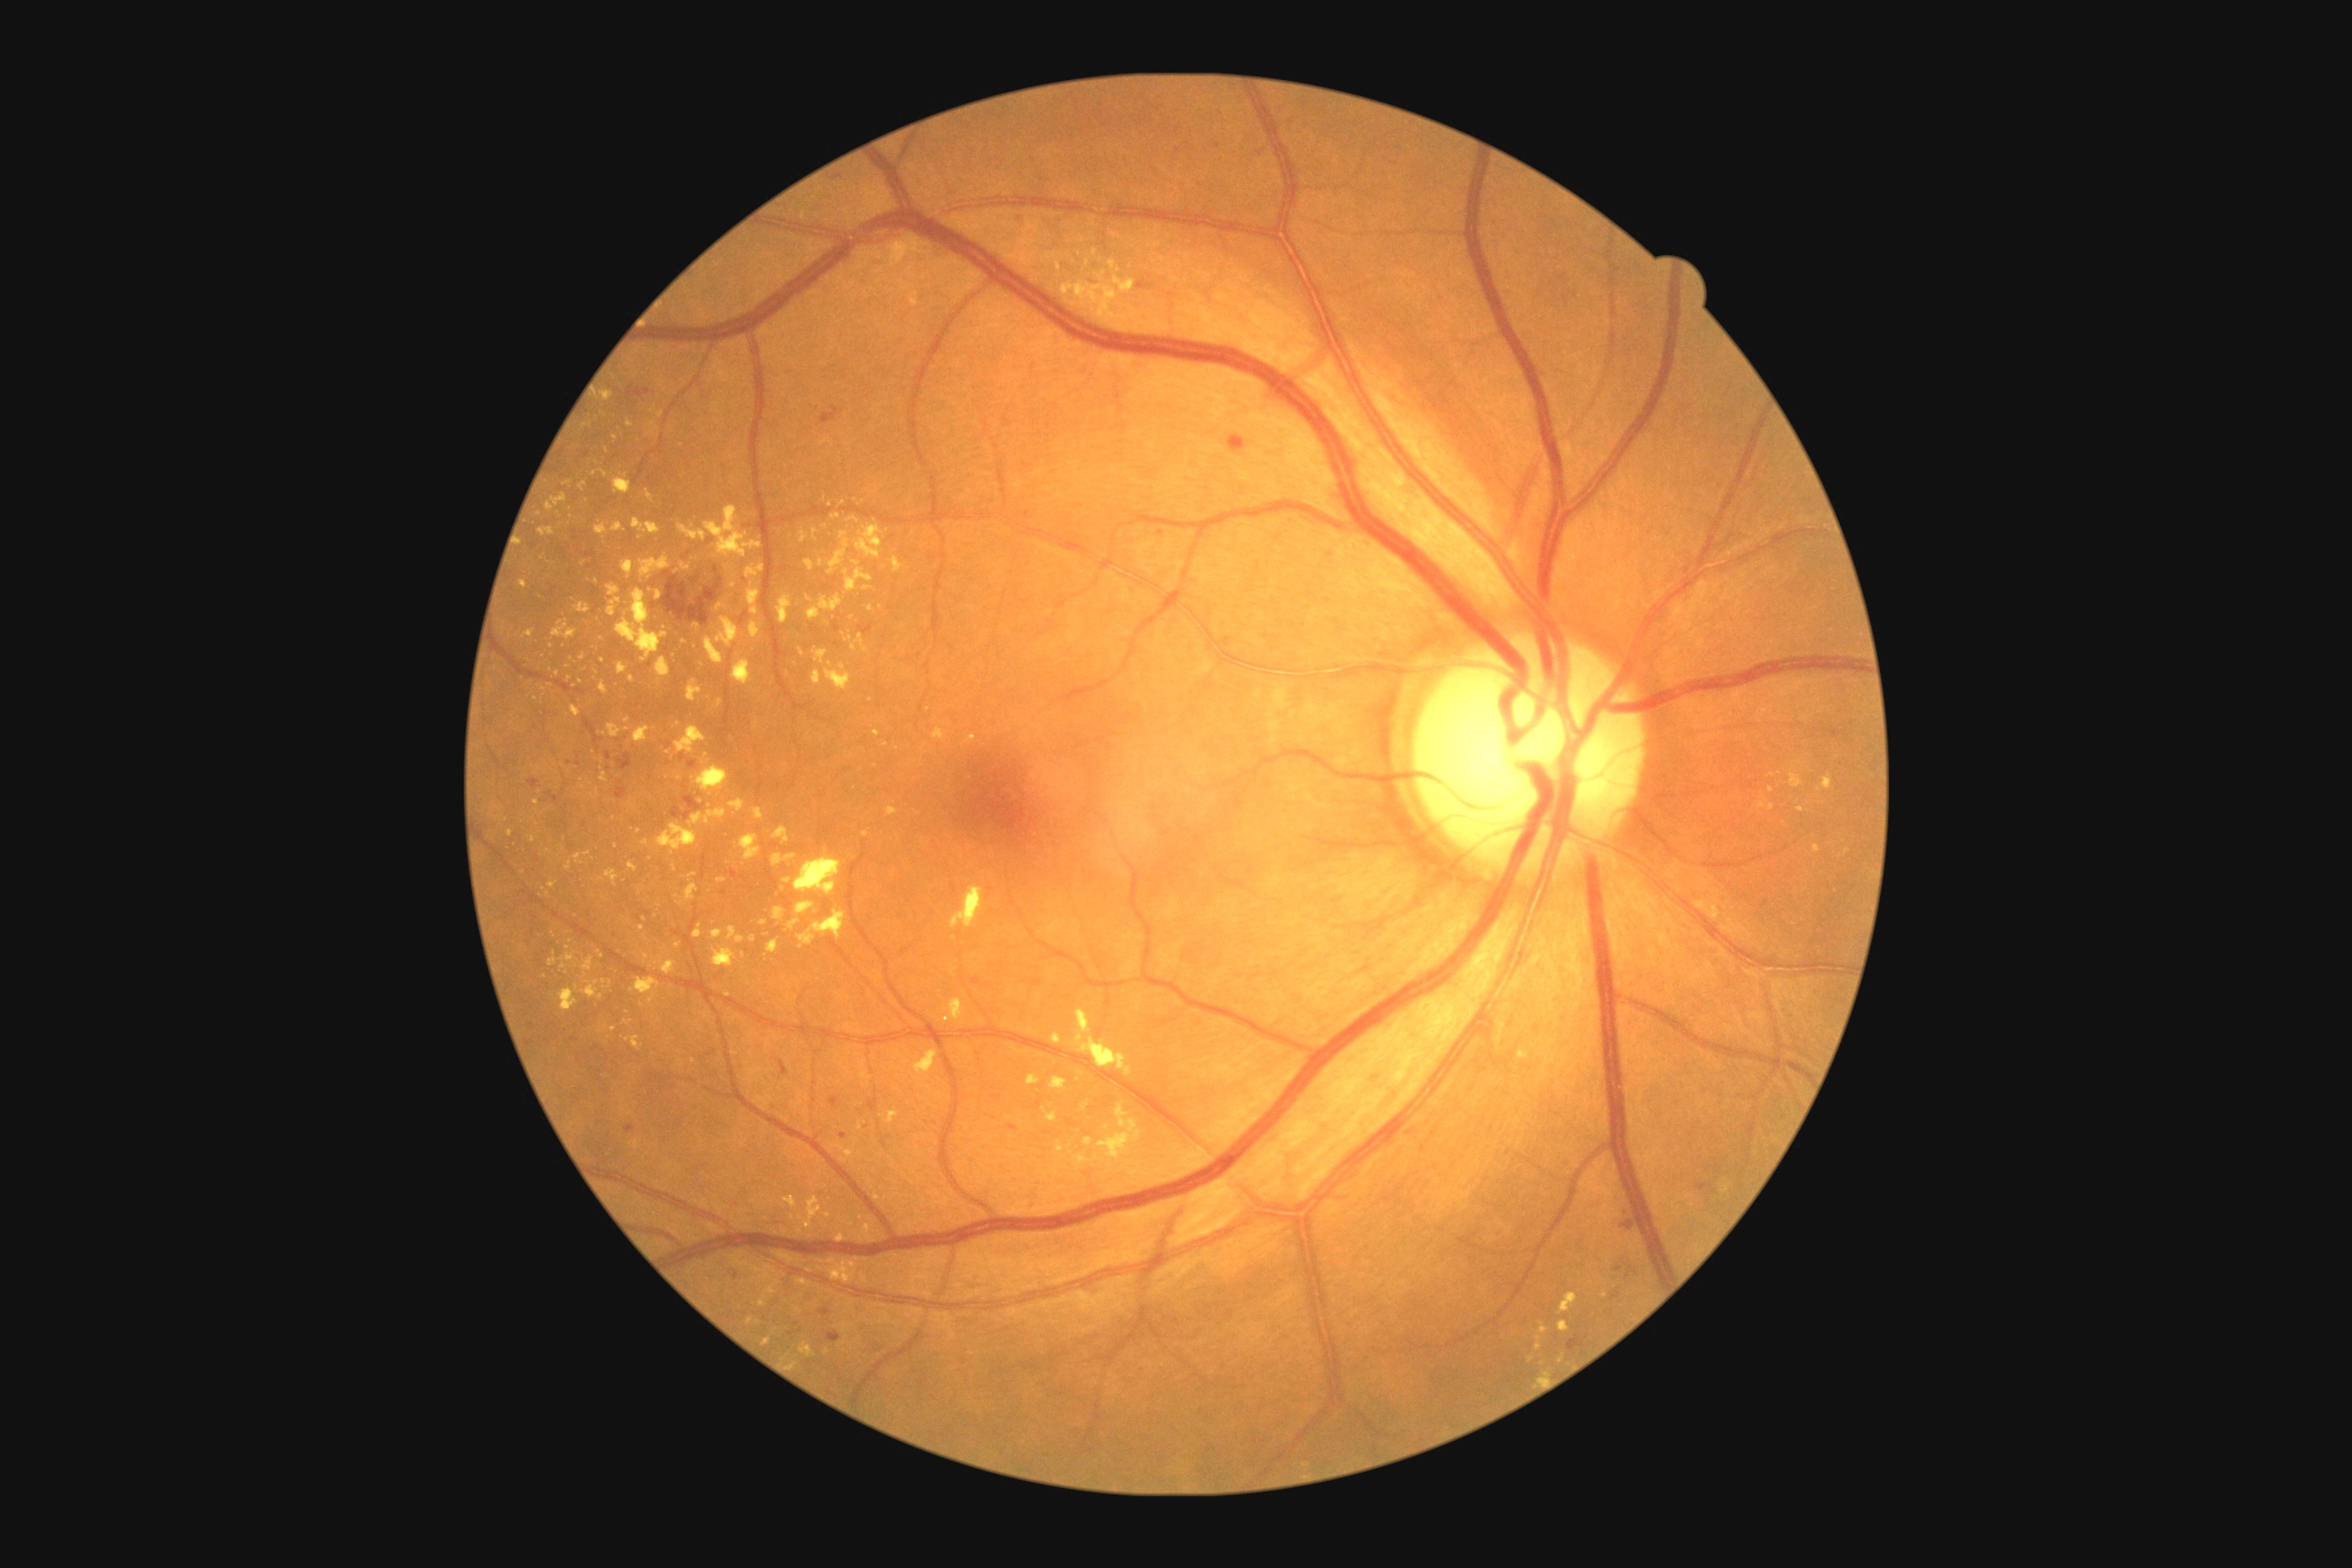
<lesions partial="true">
  <dr_grade>2</dr_grade>
  <ex partial="true">{"left": 696, "top": 765, "right": 729, "bottom": 794}, {"left": 656, "top": 591, "right": 663, "bottom": 602}, {"left": 580, "top": 654, "right": 585, "bottom": 662}, {"left": 772, "top": 854, "right": 798, "bottom": 867}, {"left": 716, "top": 879, "right": 727, "bottom": 885}, {"left": 1086, "top": 260, "right": 1092, "bottom": 268}, {"left": 591, "top": 789, "right": 600, "bottom": 799}, {"left": 789, "top": 919, "right": 801, "bottom": 930}, {"left": 848, "top": 1298, "right": 856, "bottom": 1306}, {"left": 861, "top": 1224, "right": 874, "bottom": 1244}, {"left": 560, "top": 952, "right": 576, "bottom": 963}, {"left": 607, "top": 585, "right": 622, "bottom": 618}</ex>
  <ex_small><point>597, 672</point>, <point>675, 869</point>, <point>551, 563</point>, <point>652, 411</point>, <point>843, 503</point>, <point>1604, 1295</point></ex_small>
</lesions>